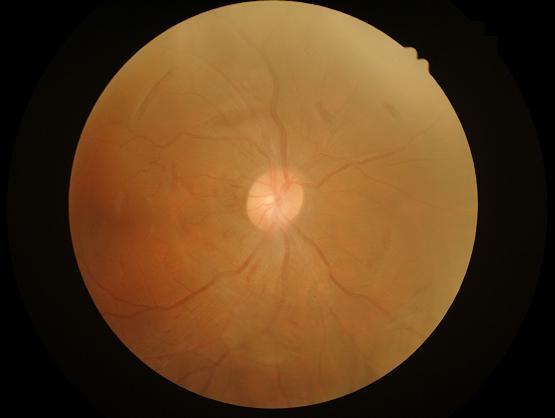

Illumination/color = no over- or under-exposure
Focus = reduced sharpness with visible blur
Contrast = narrow intensity range, structures hard to distinguish
Overall image quality = inadequate for clinical interpretation